Retinal fundus photograph: 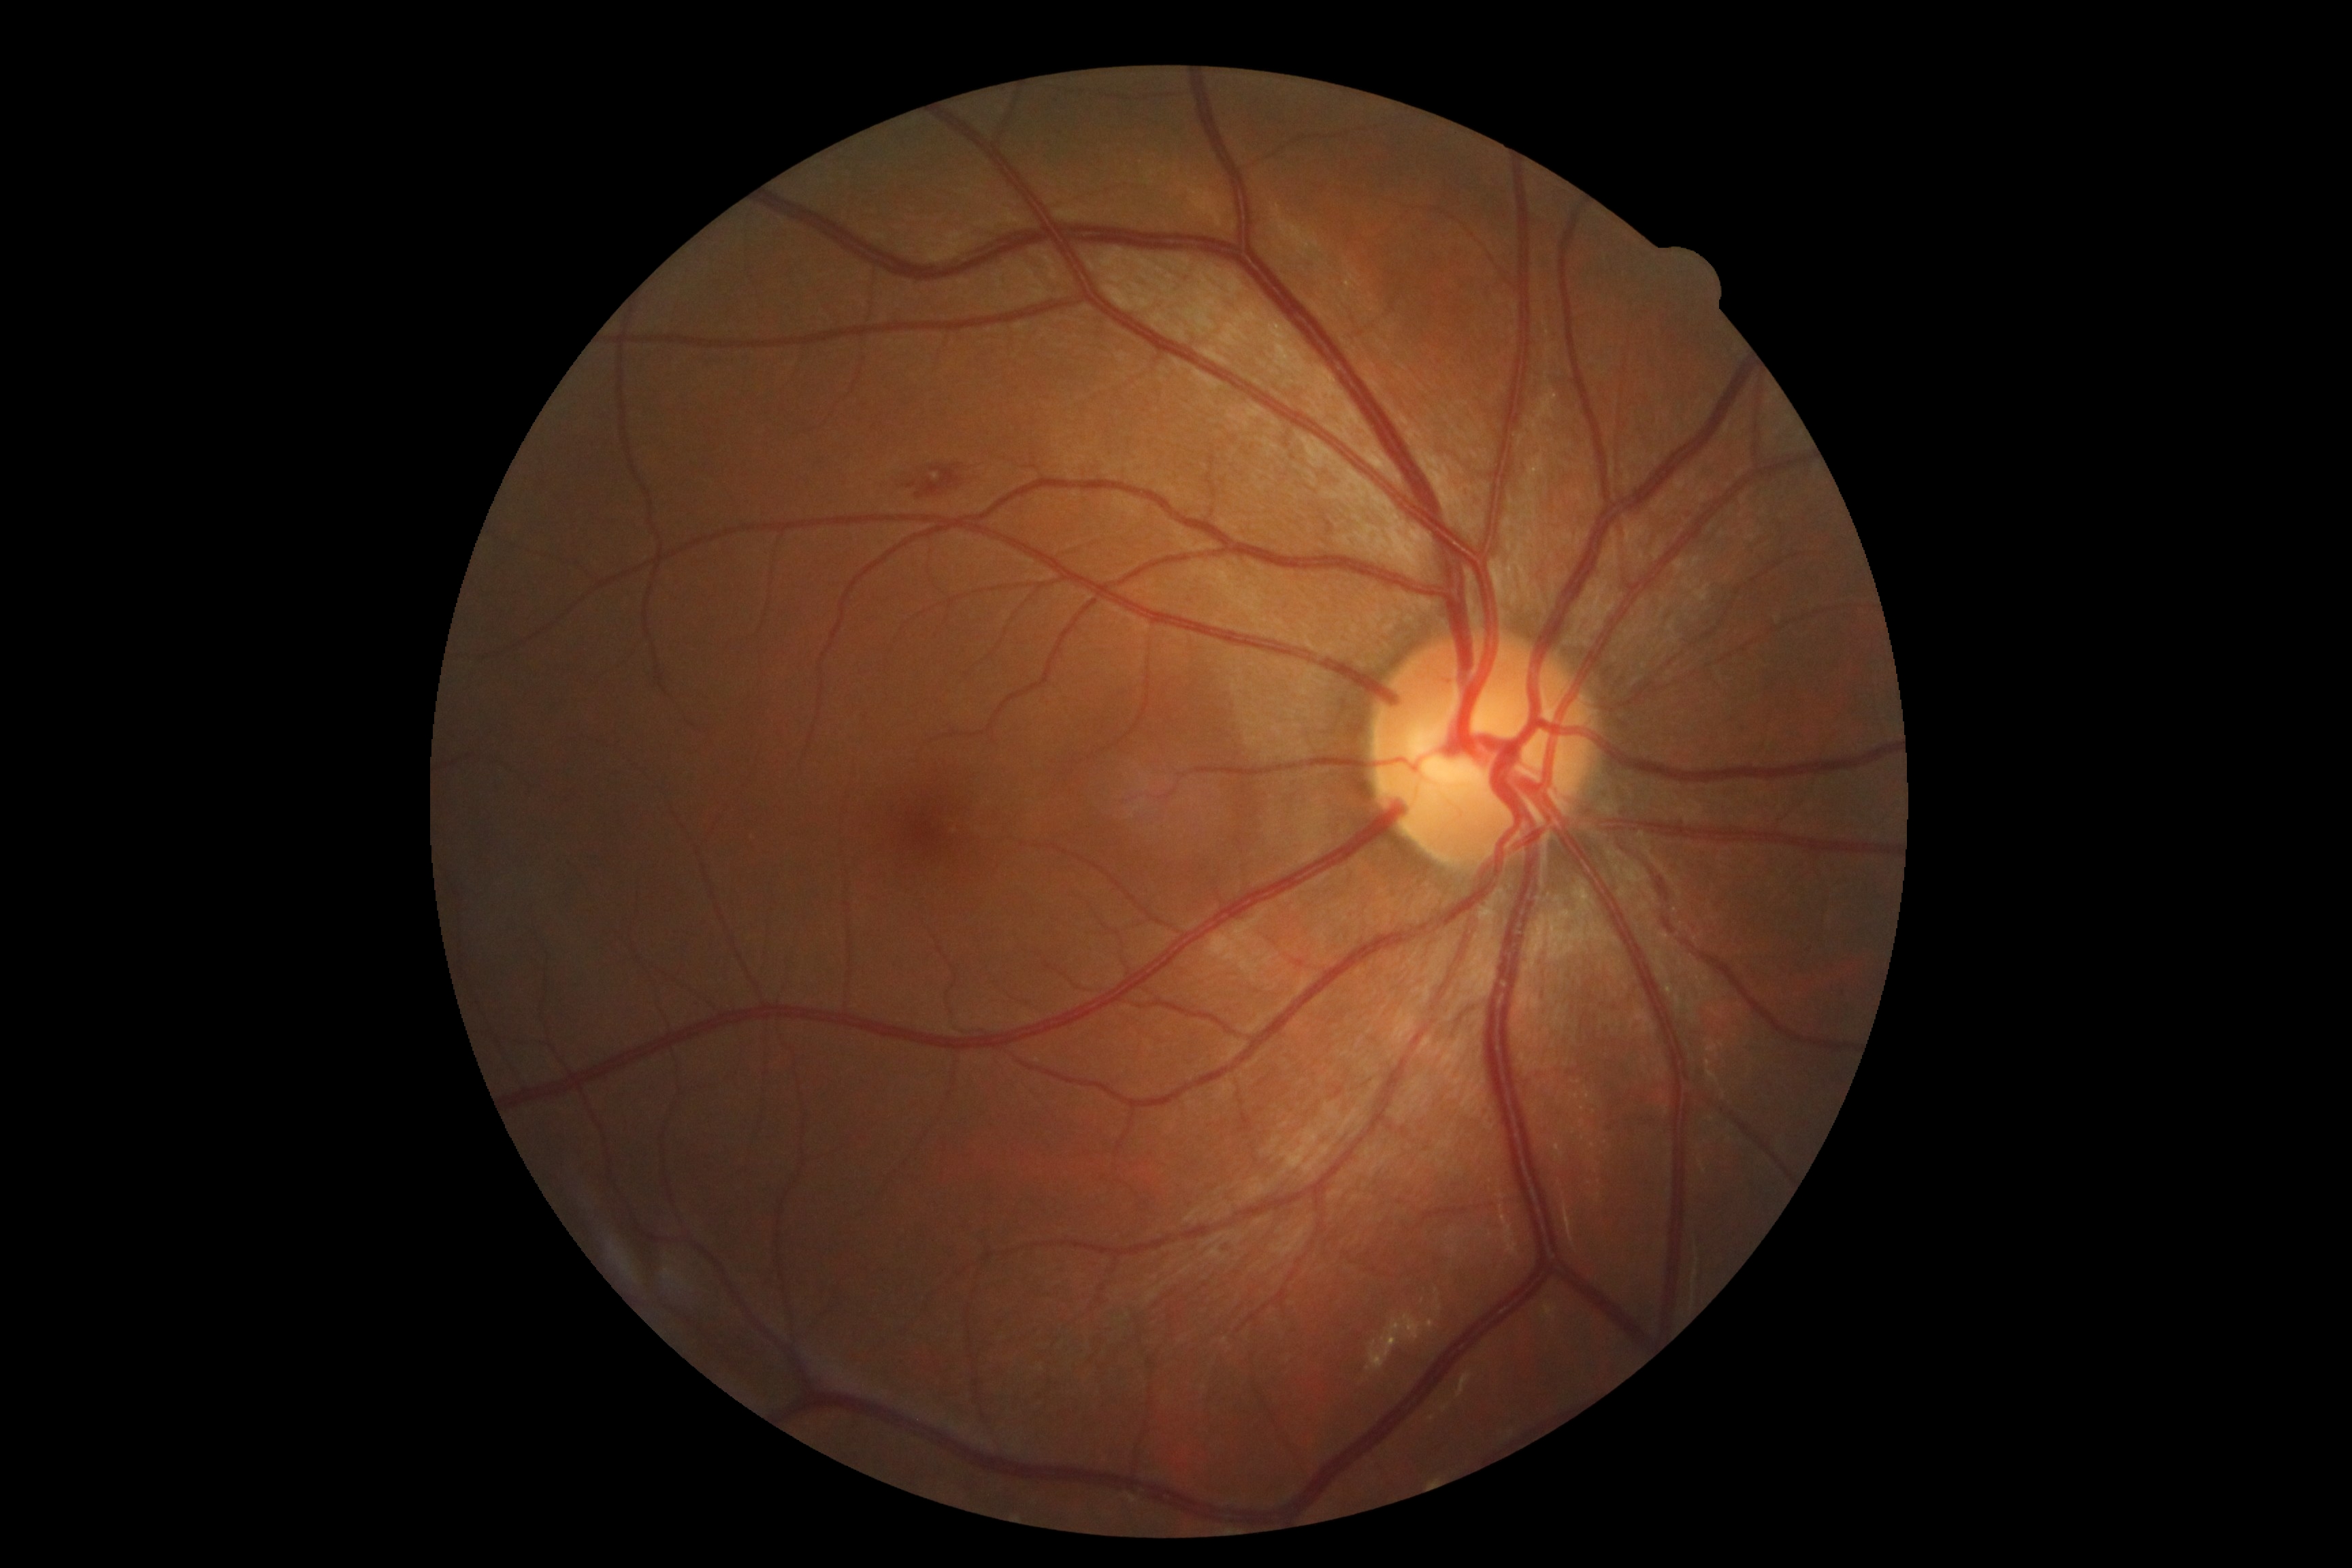

  dr_grade: 2